45° FOV, modified Davis grading, camera: NIDEK AFC-230 — 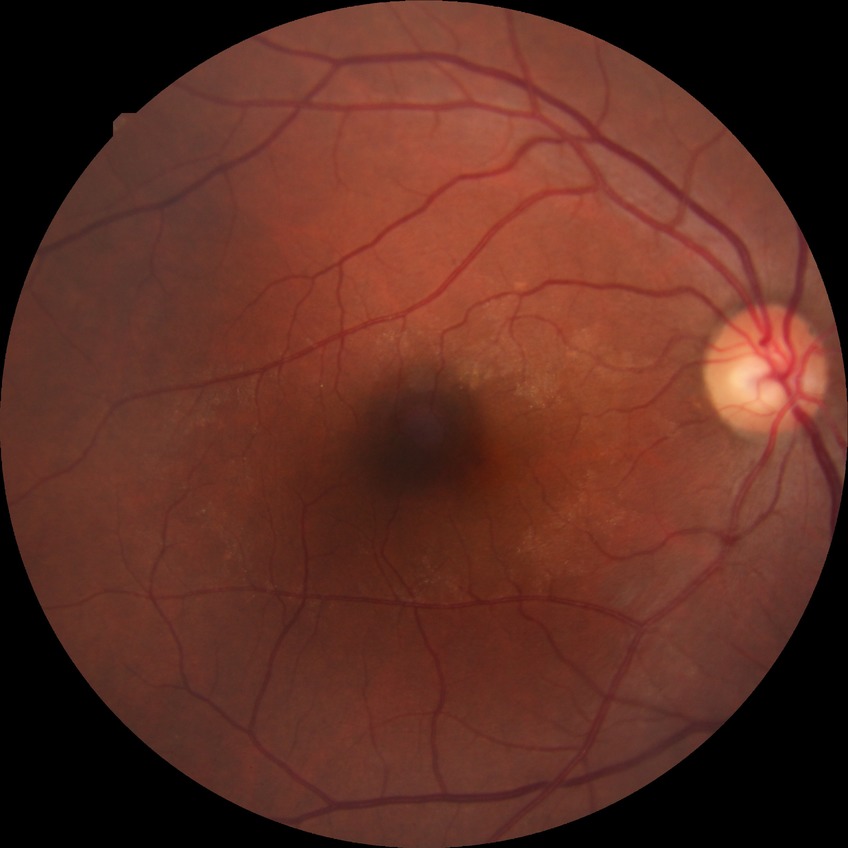

retinopathy stage = no diabetic retinopathy.